Field includes the optic disc and macula
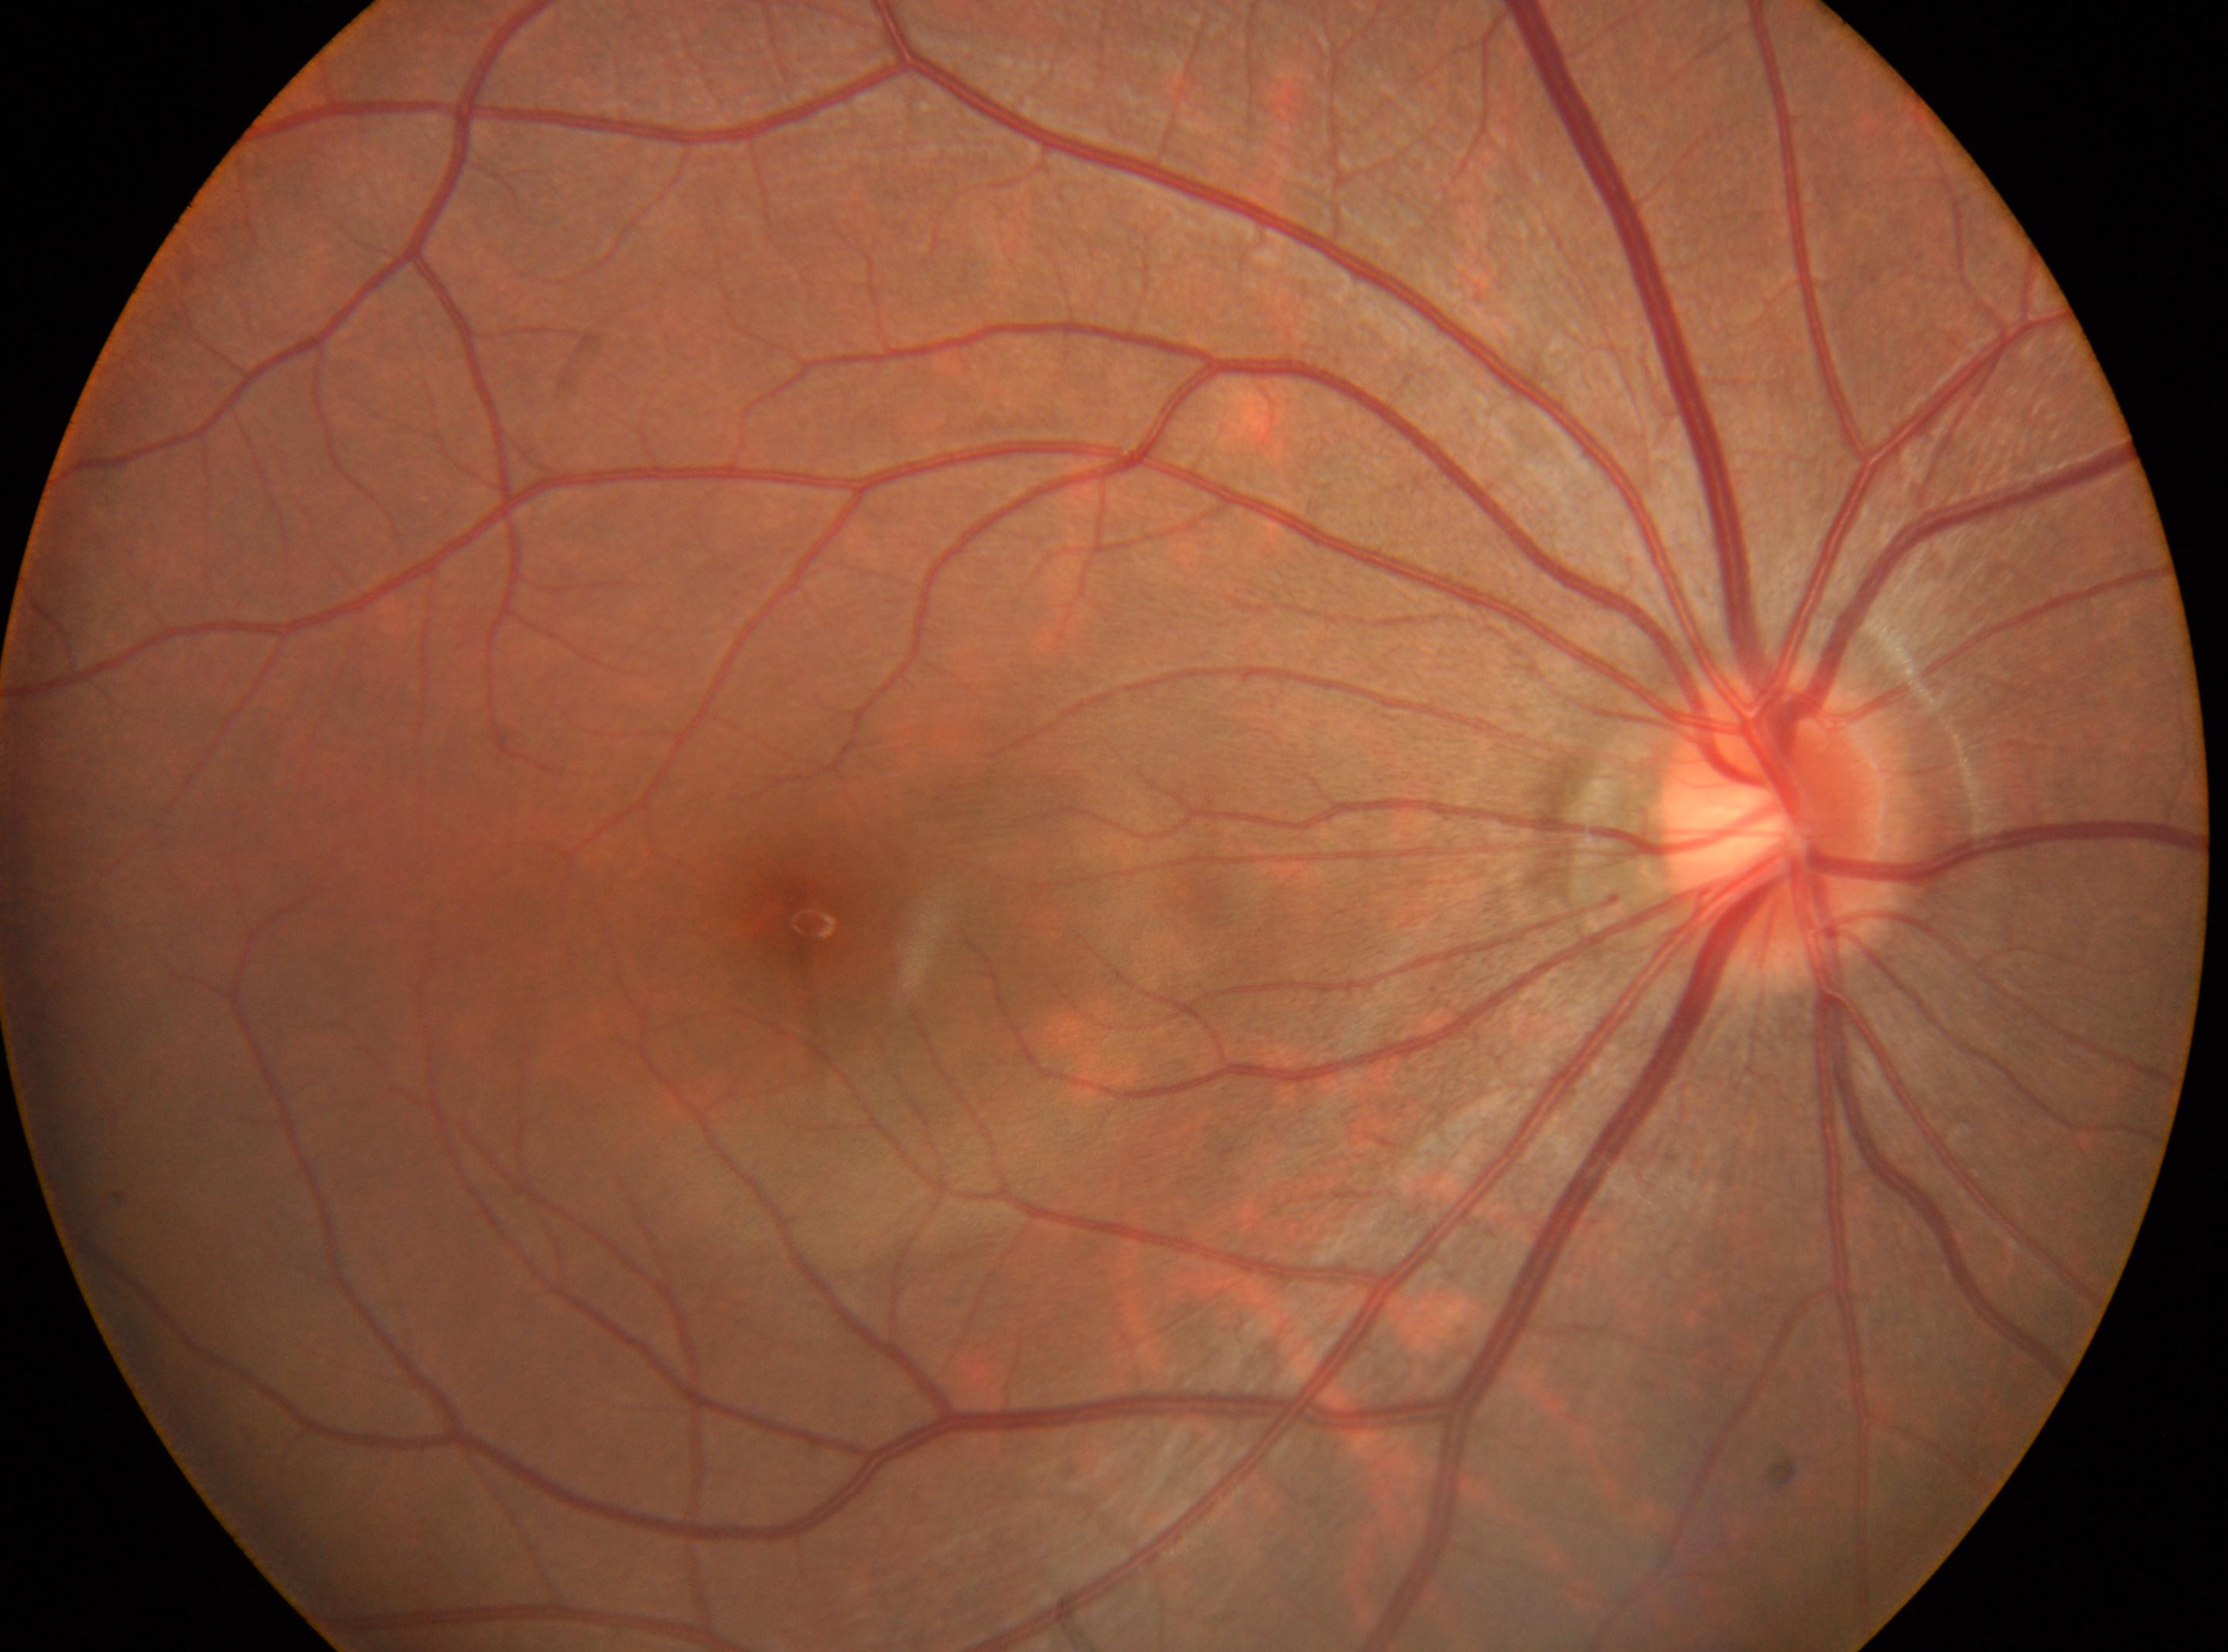

No signs of diabetic retinopathy.
Optic nerve head located at (x=1779, y=821).
This is the right eye.
DR grade: no apparent diabetic retinopathy (0) — no visible signs of diabetic retinopathy.
Fovea located at (x=803, y=922).